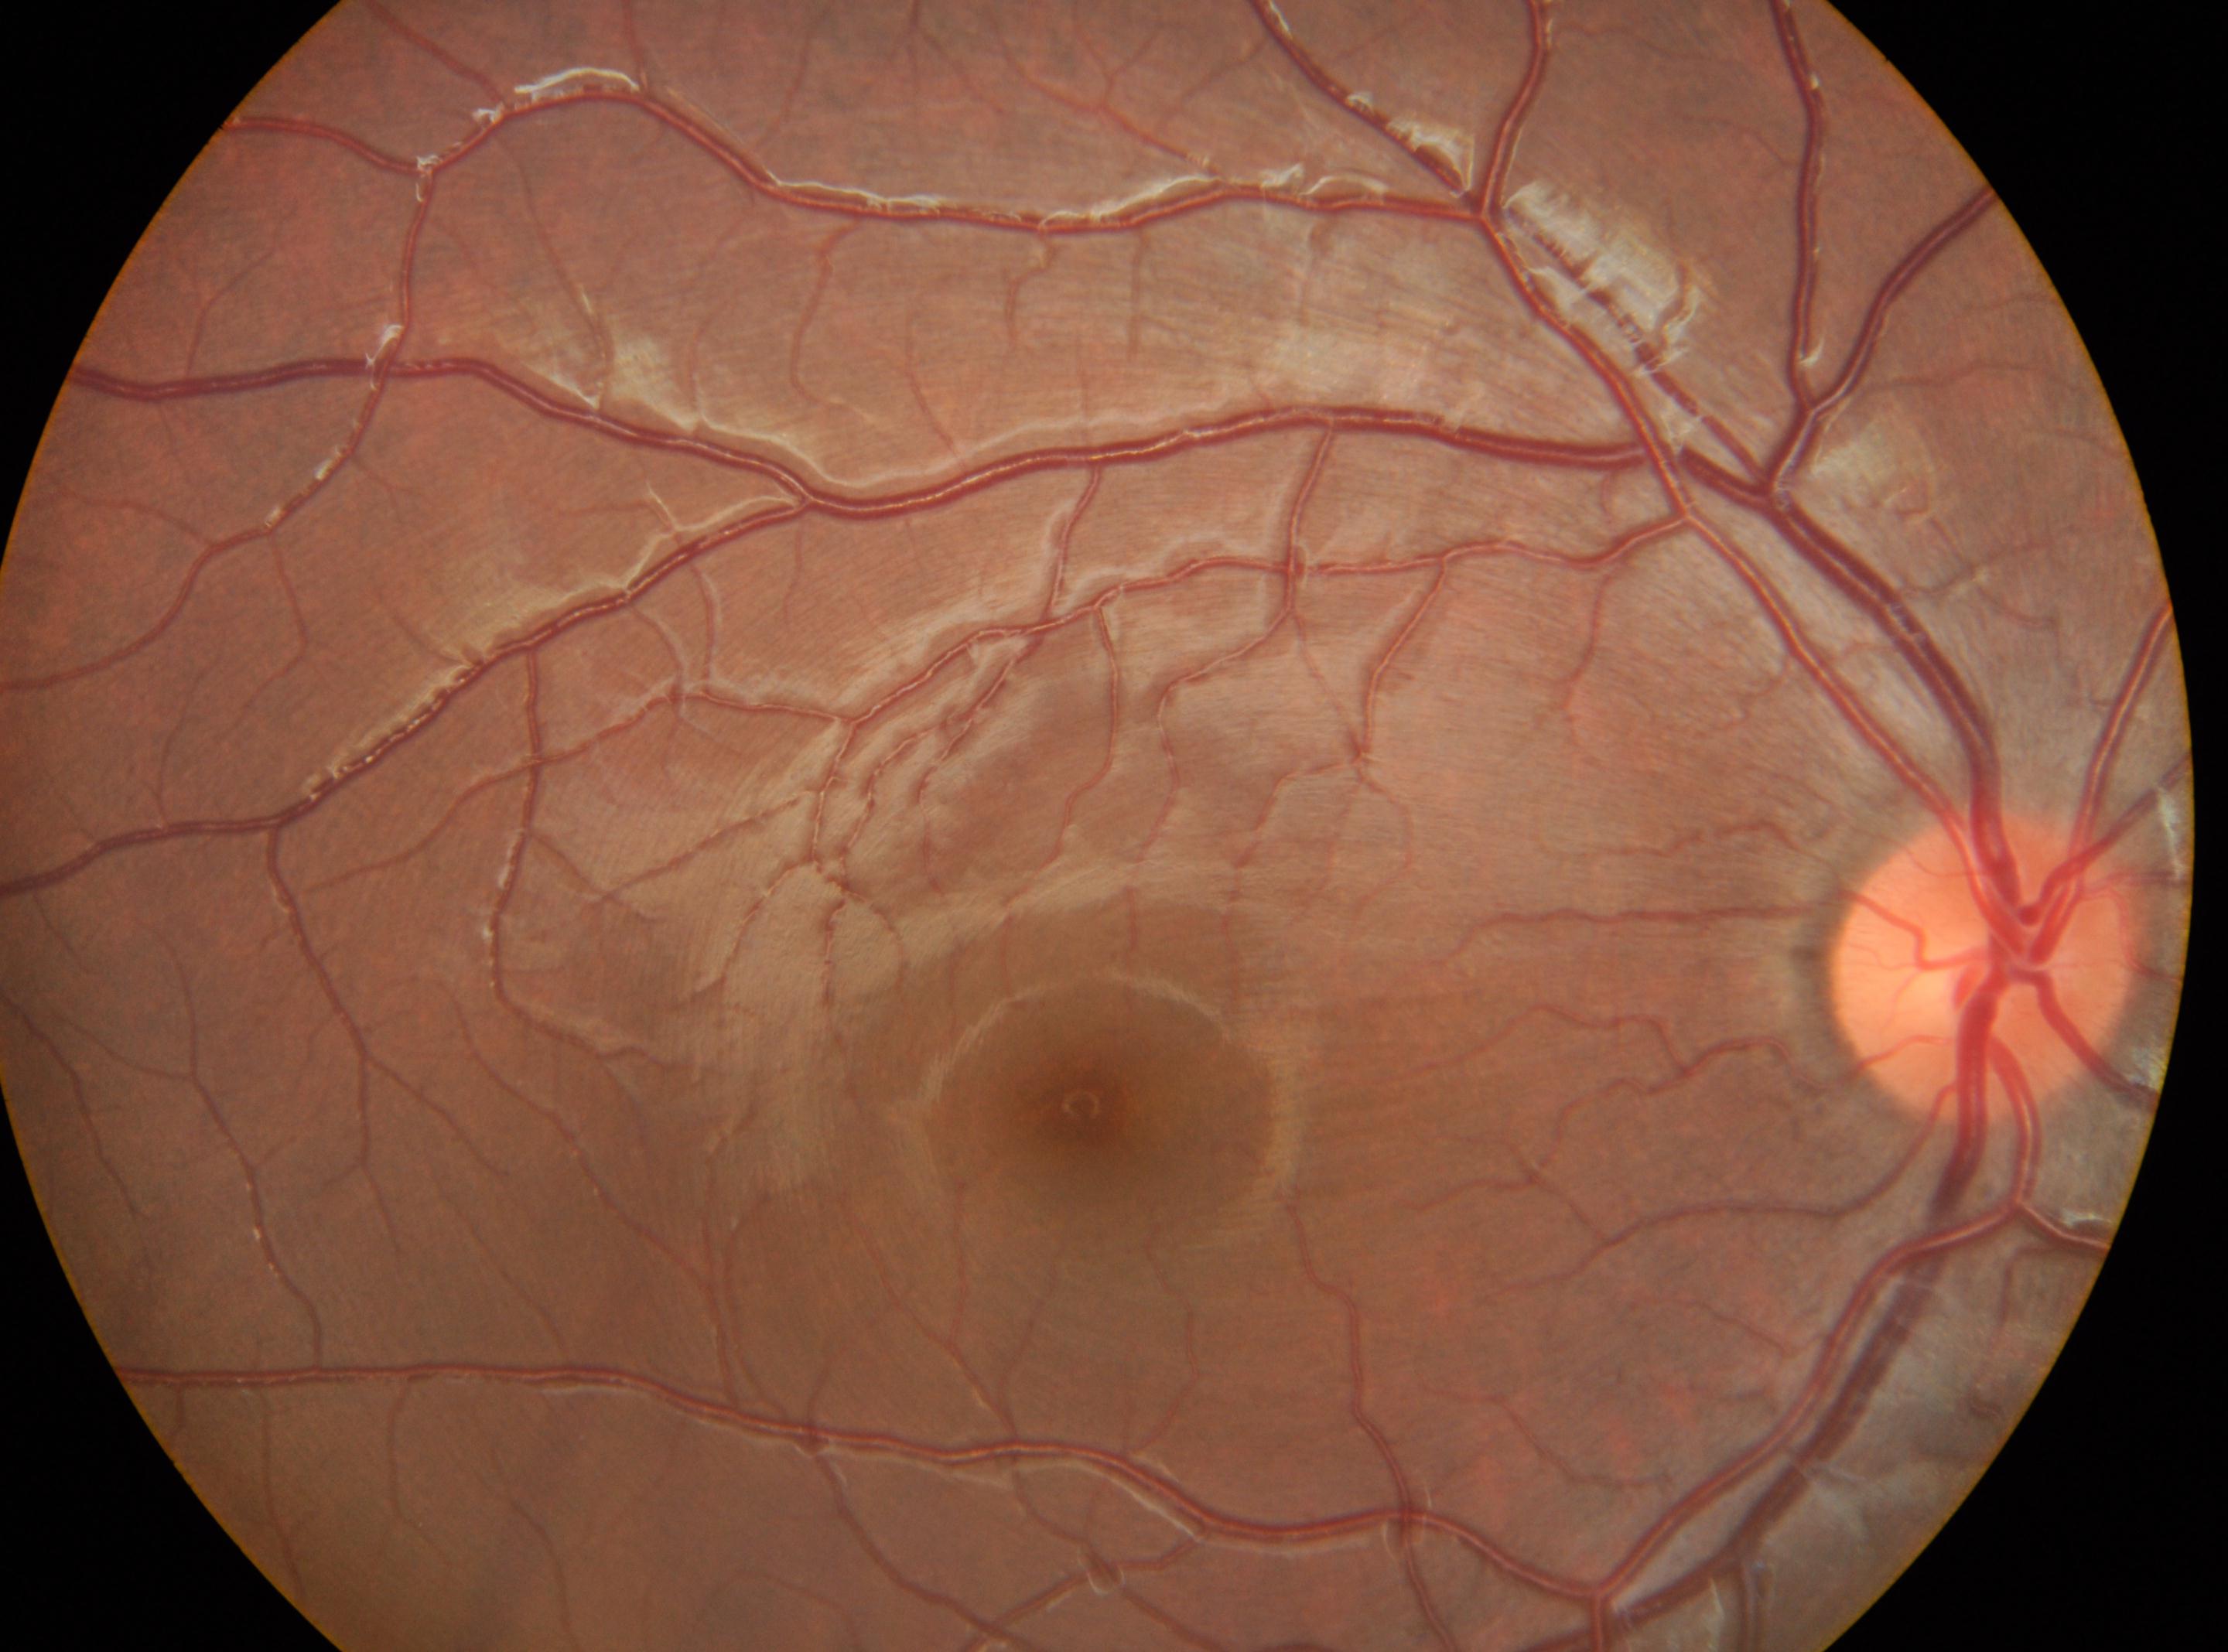
Diabetic retinopathy is grade 0. The foveal center is at 1082px, 1103px. This is the right eye. Optic disc center: 1980px, 965px.